60-degree field of view — 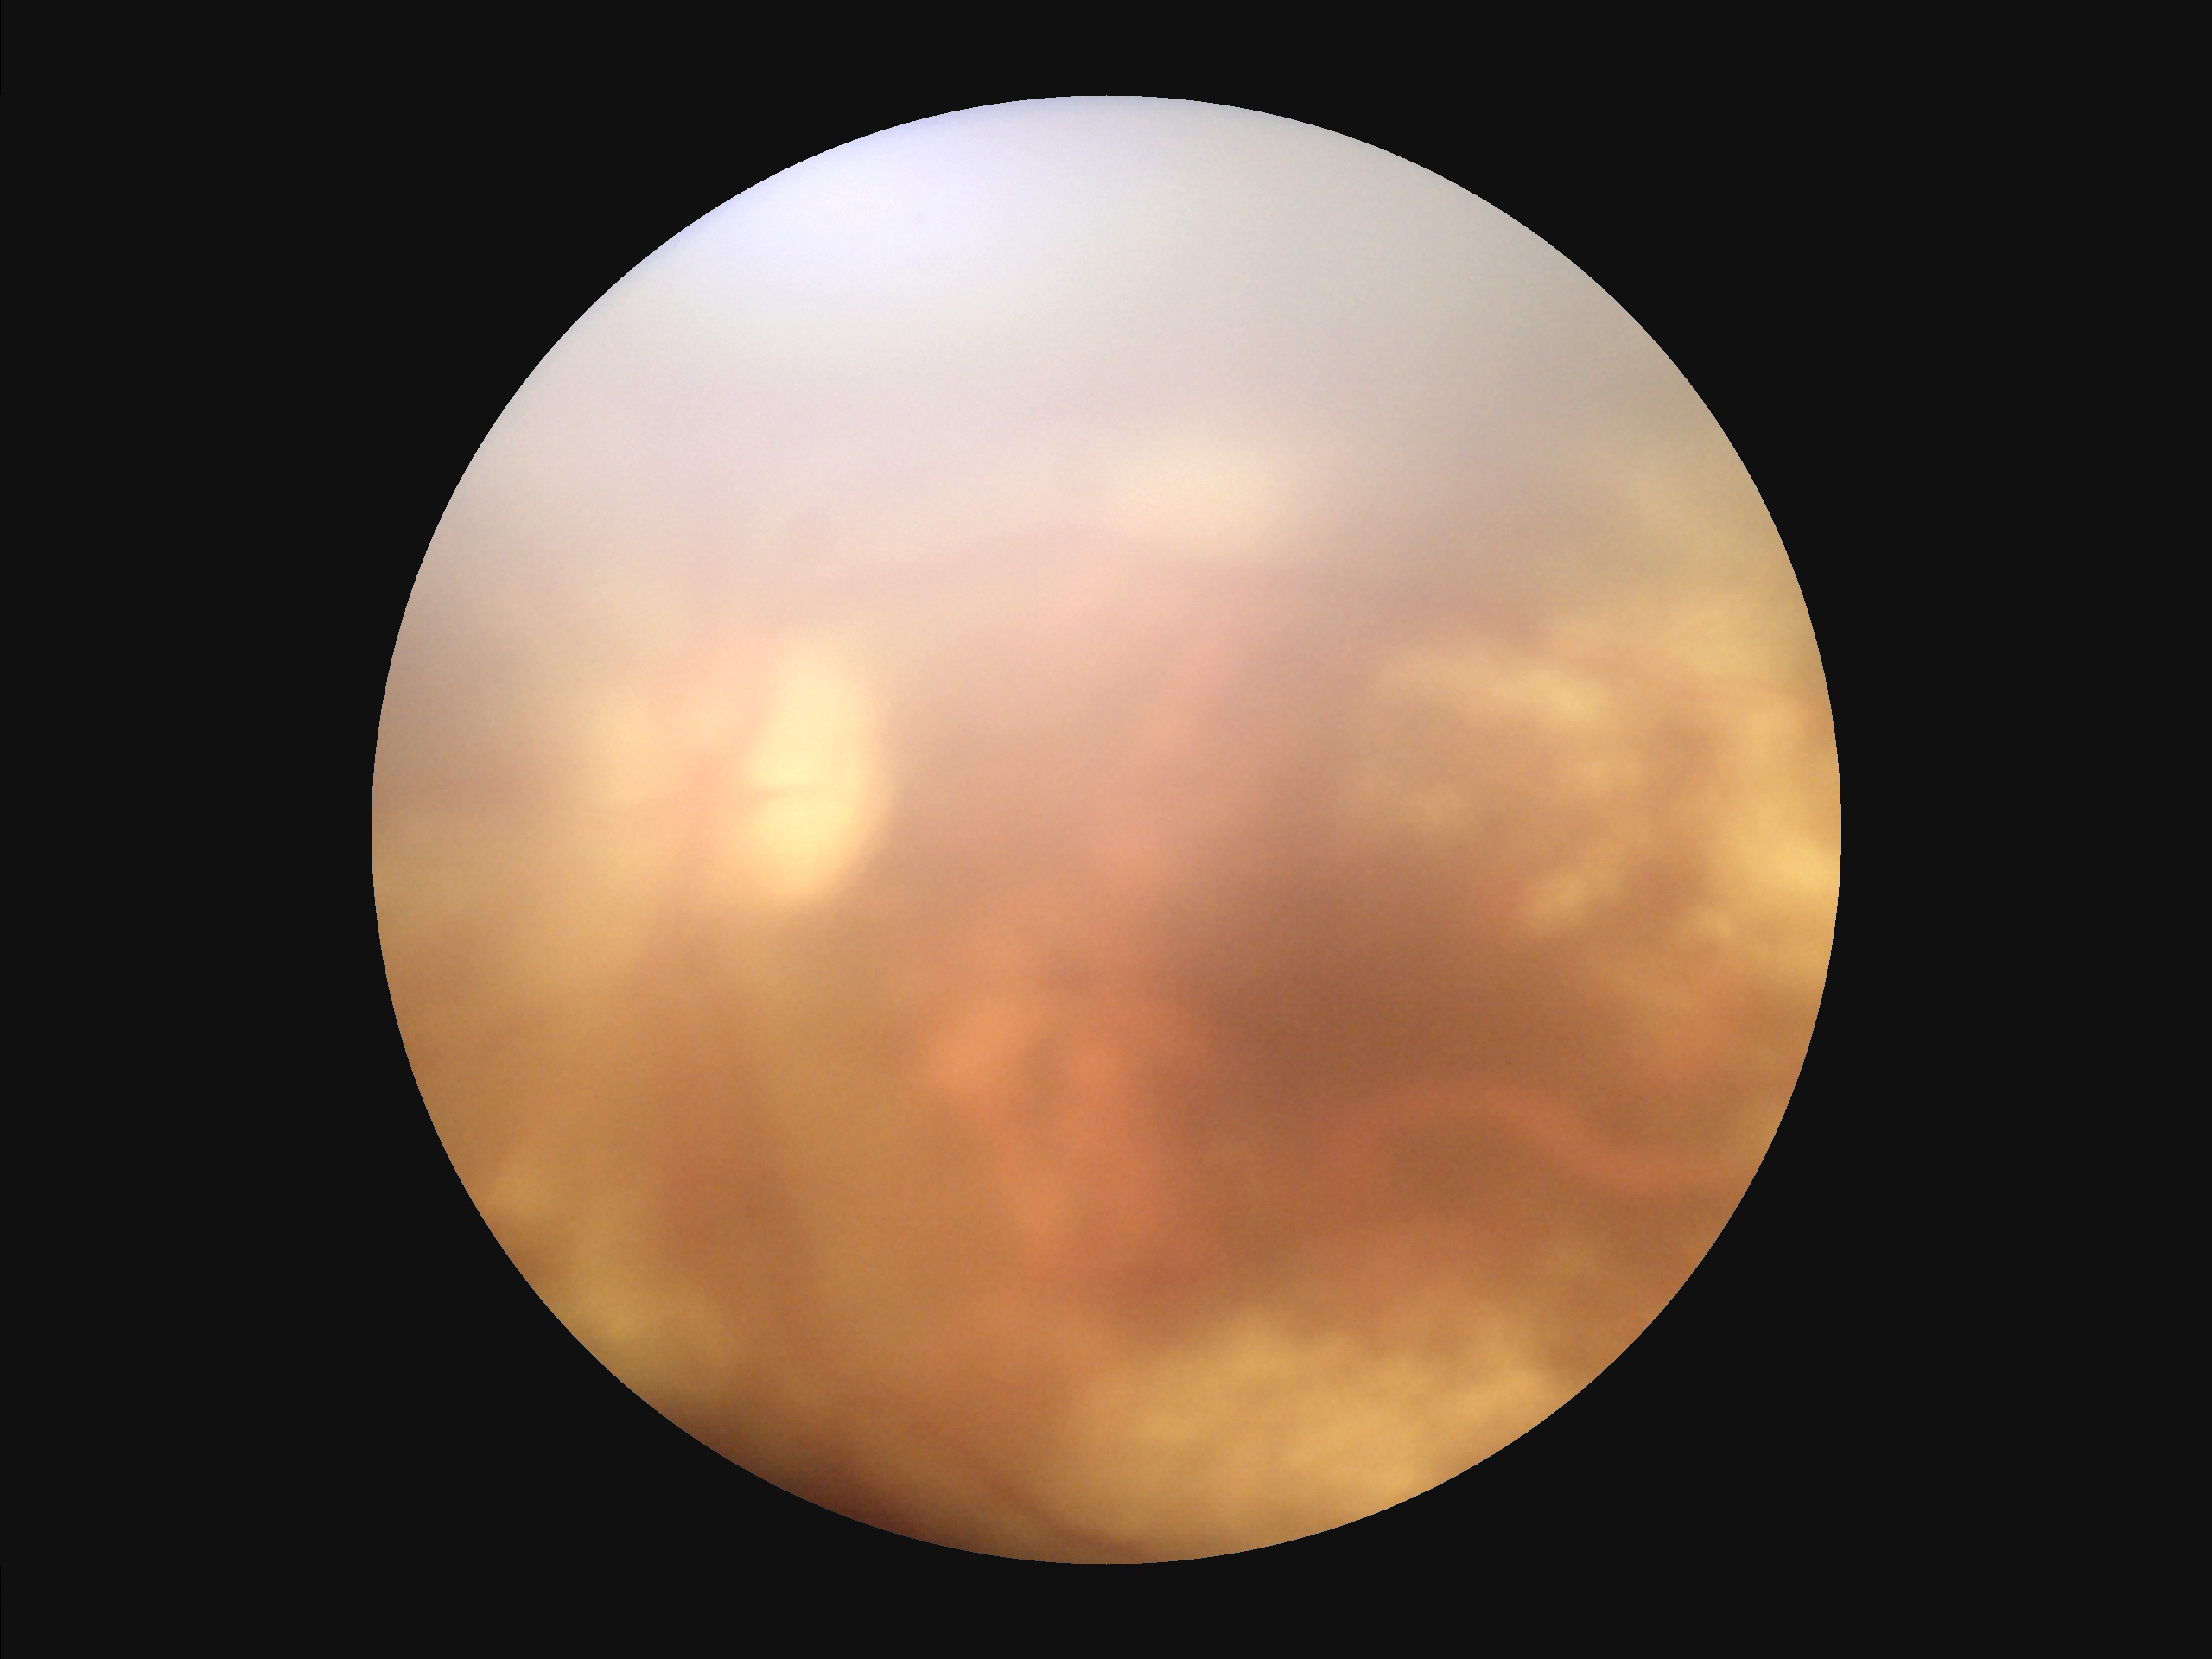
Illumination and color are suboptimal. Reduced sharpness with visible blur. Image quality is inadequate for diagnostic use. Poor dynamic range.